Captured with the Clarity RetCam 3 (130° field of view) · image size 640x480 · infant wide-field fundus photograph
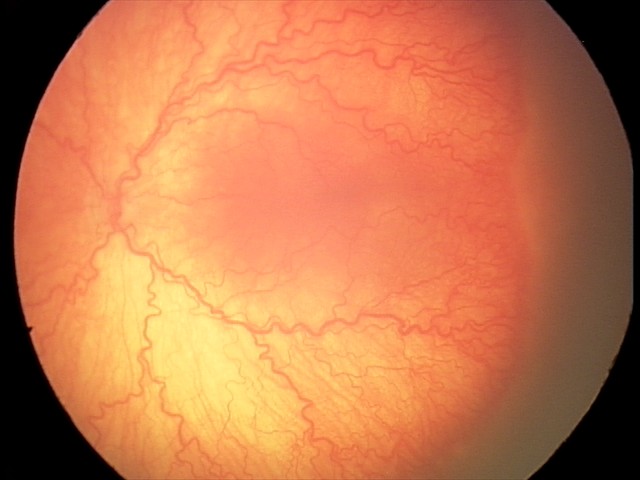
Plus disease was diagnosed. Screening series with aggressive retinopathy of prematurity.